45° field of view, color fundus image.
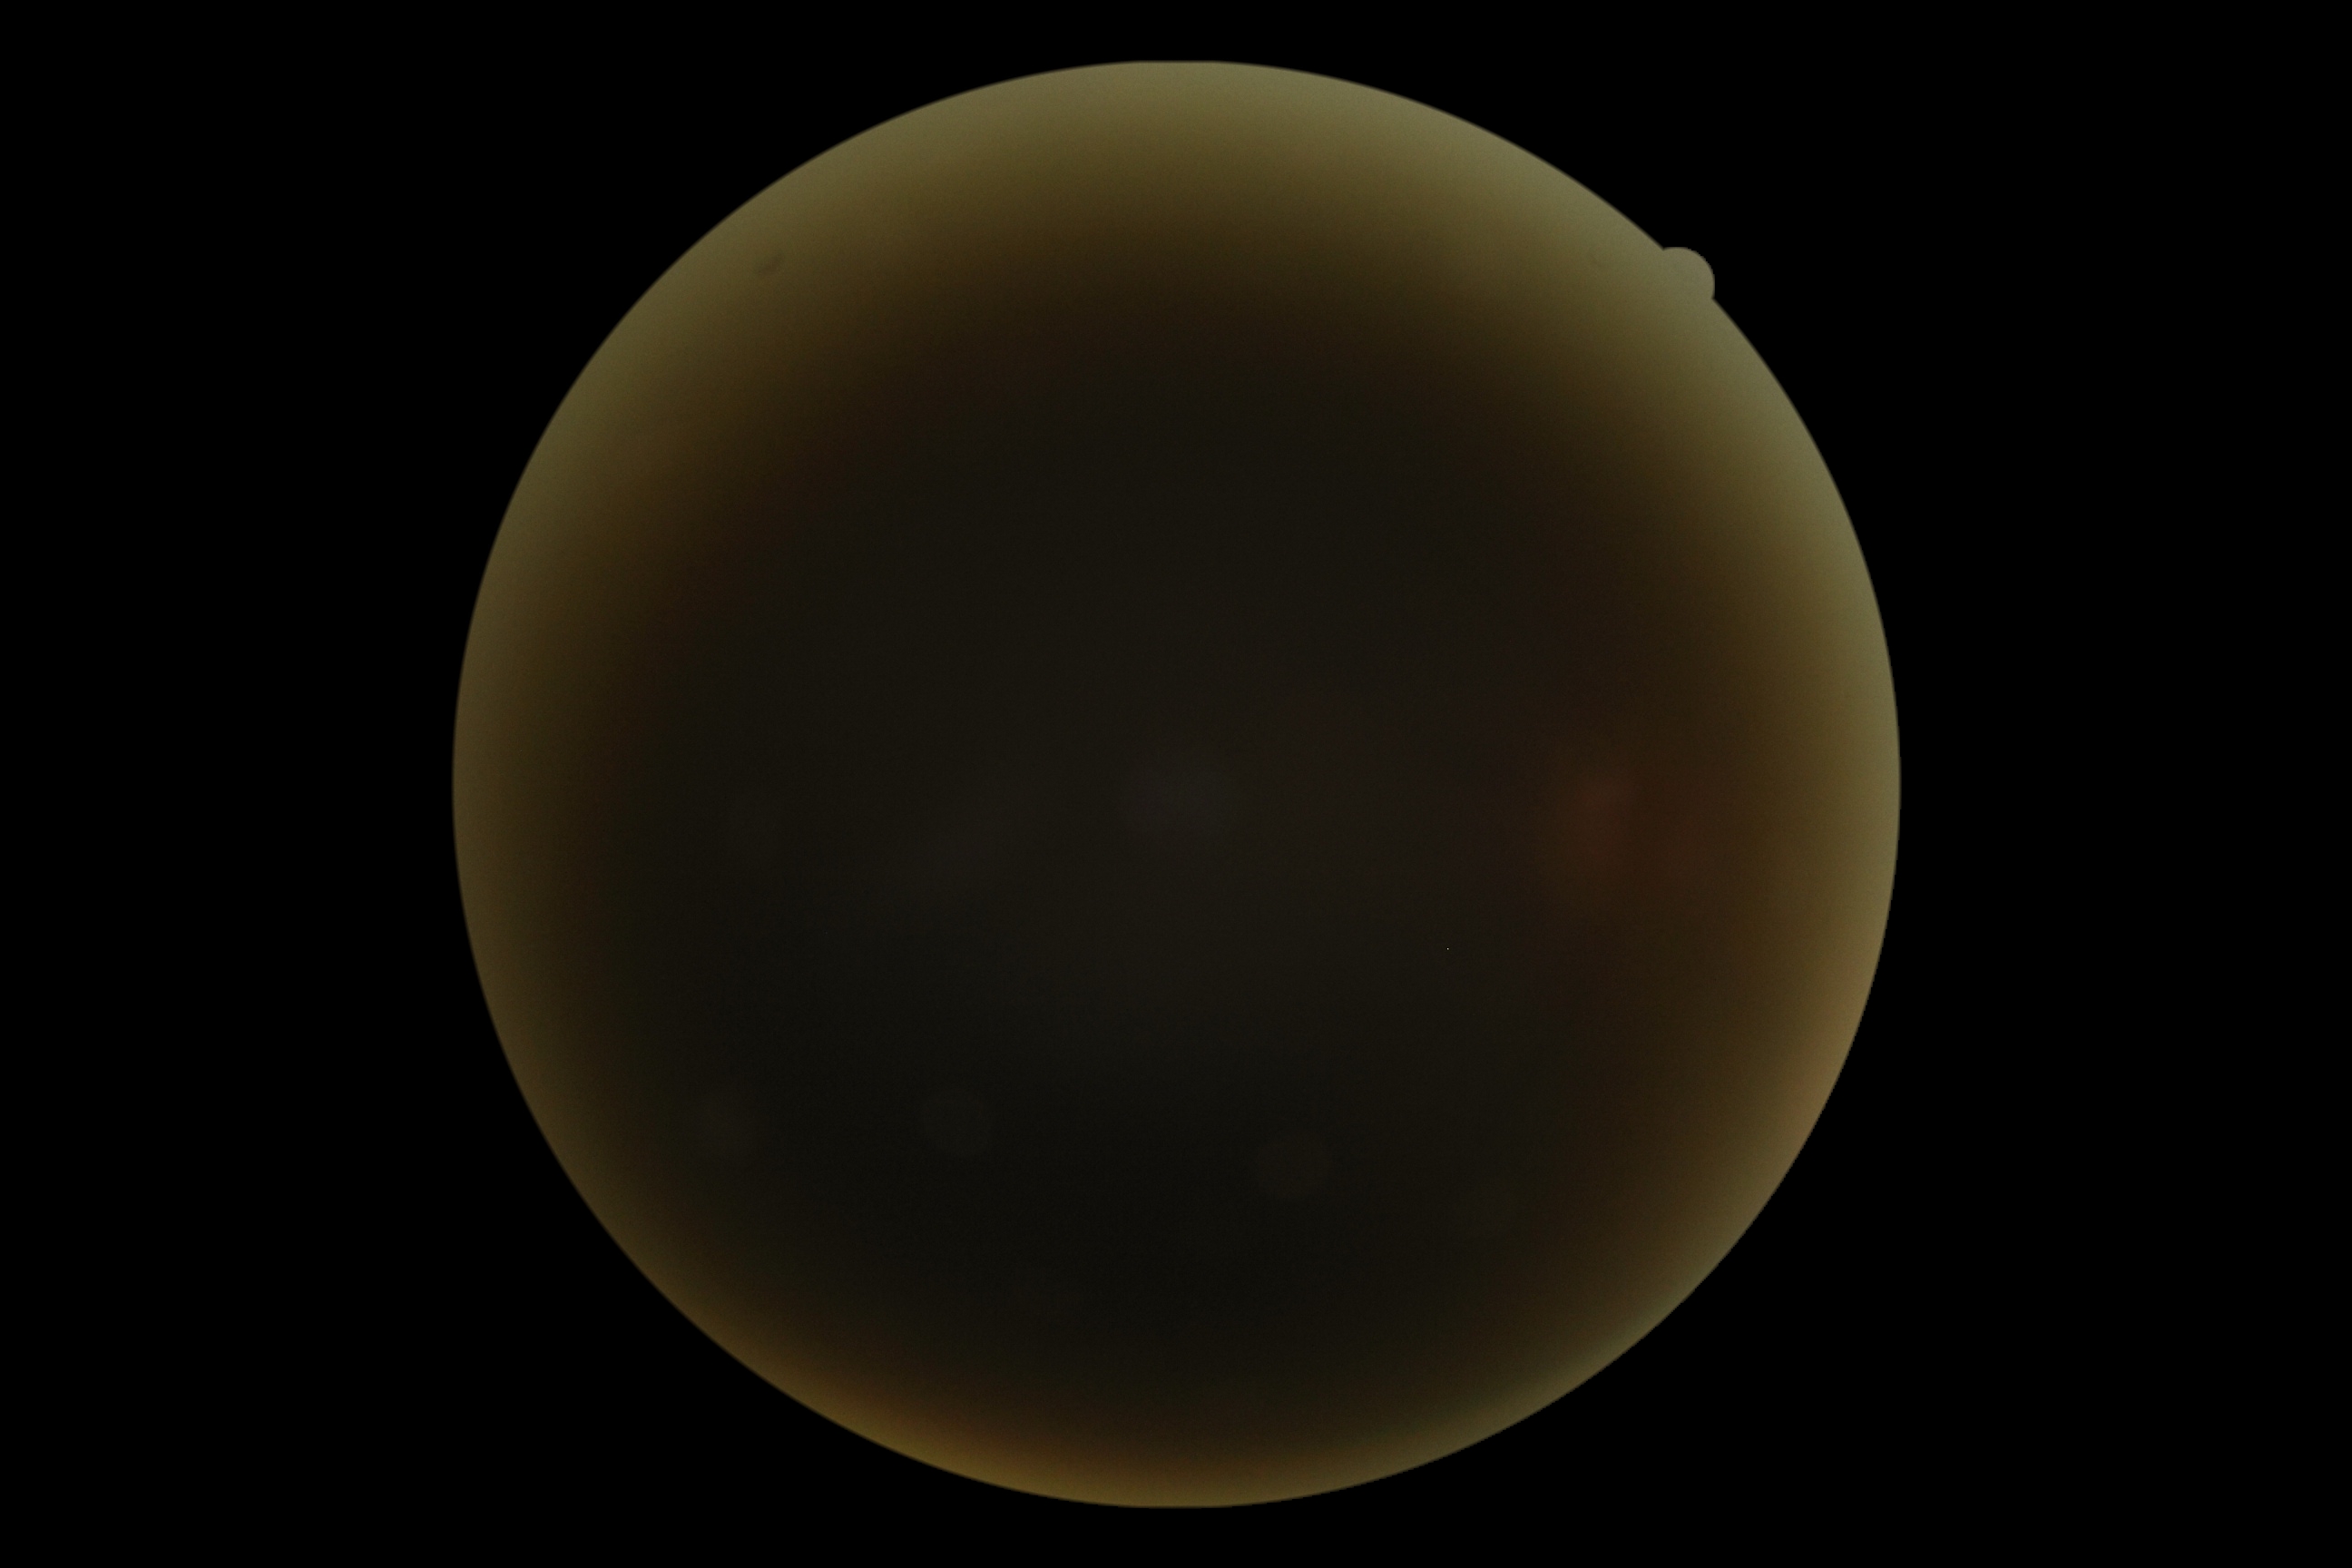

Diabetic retinopathy (DR) is ungradable.